2212 by 1659 pixels:
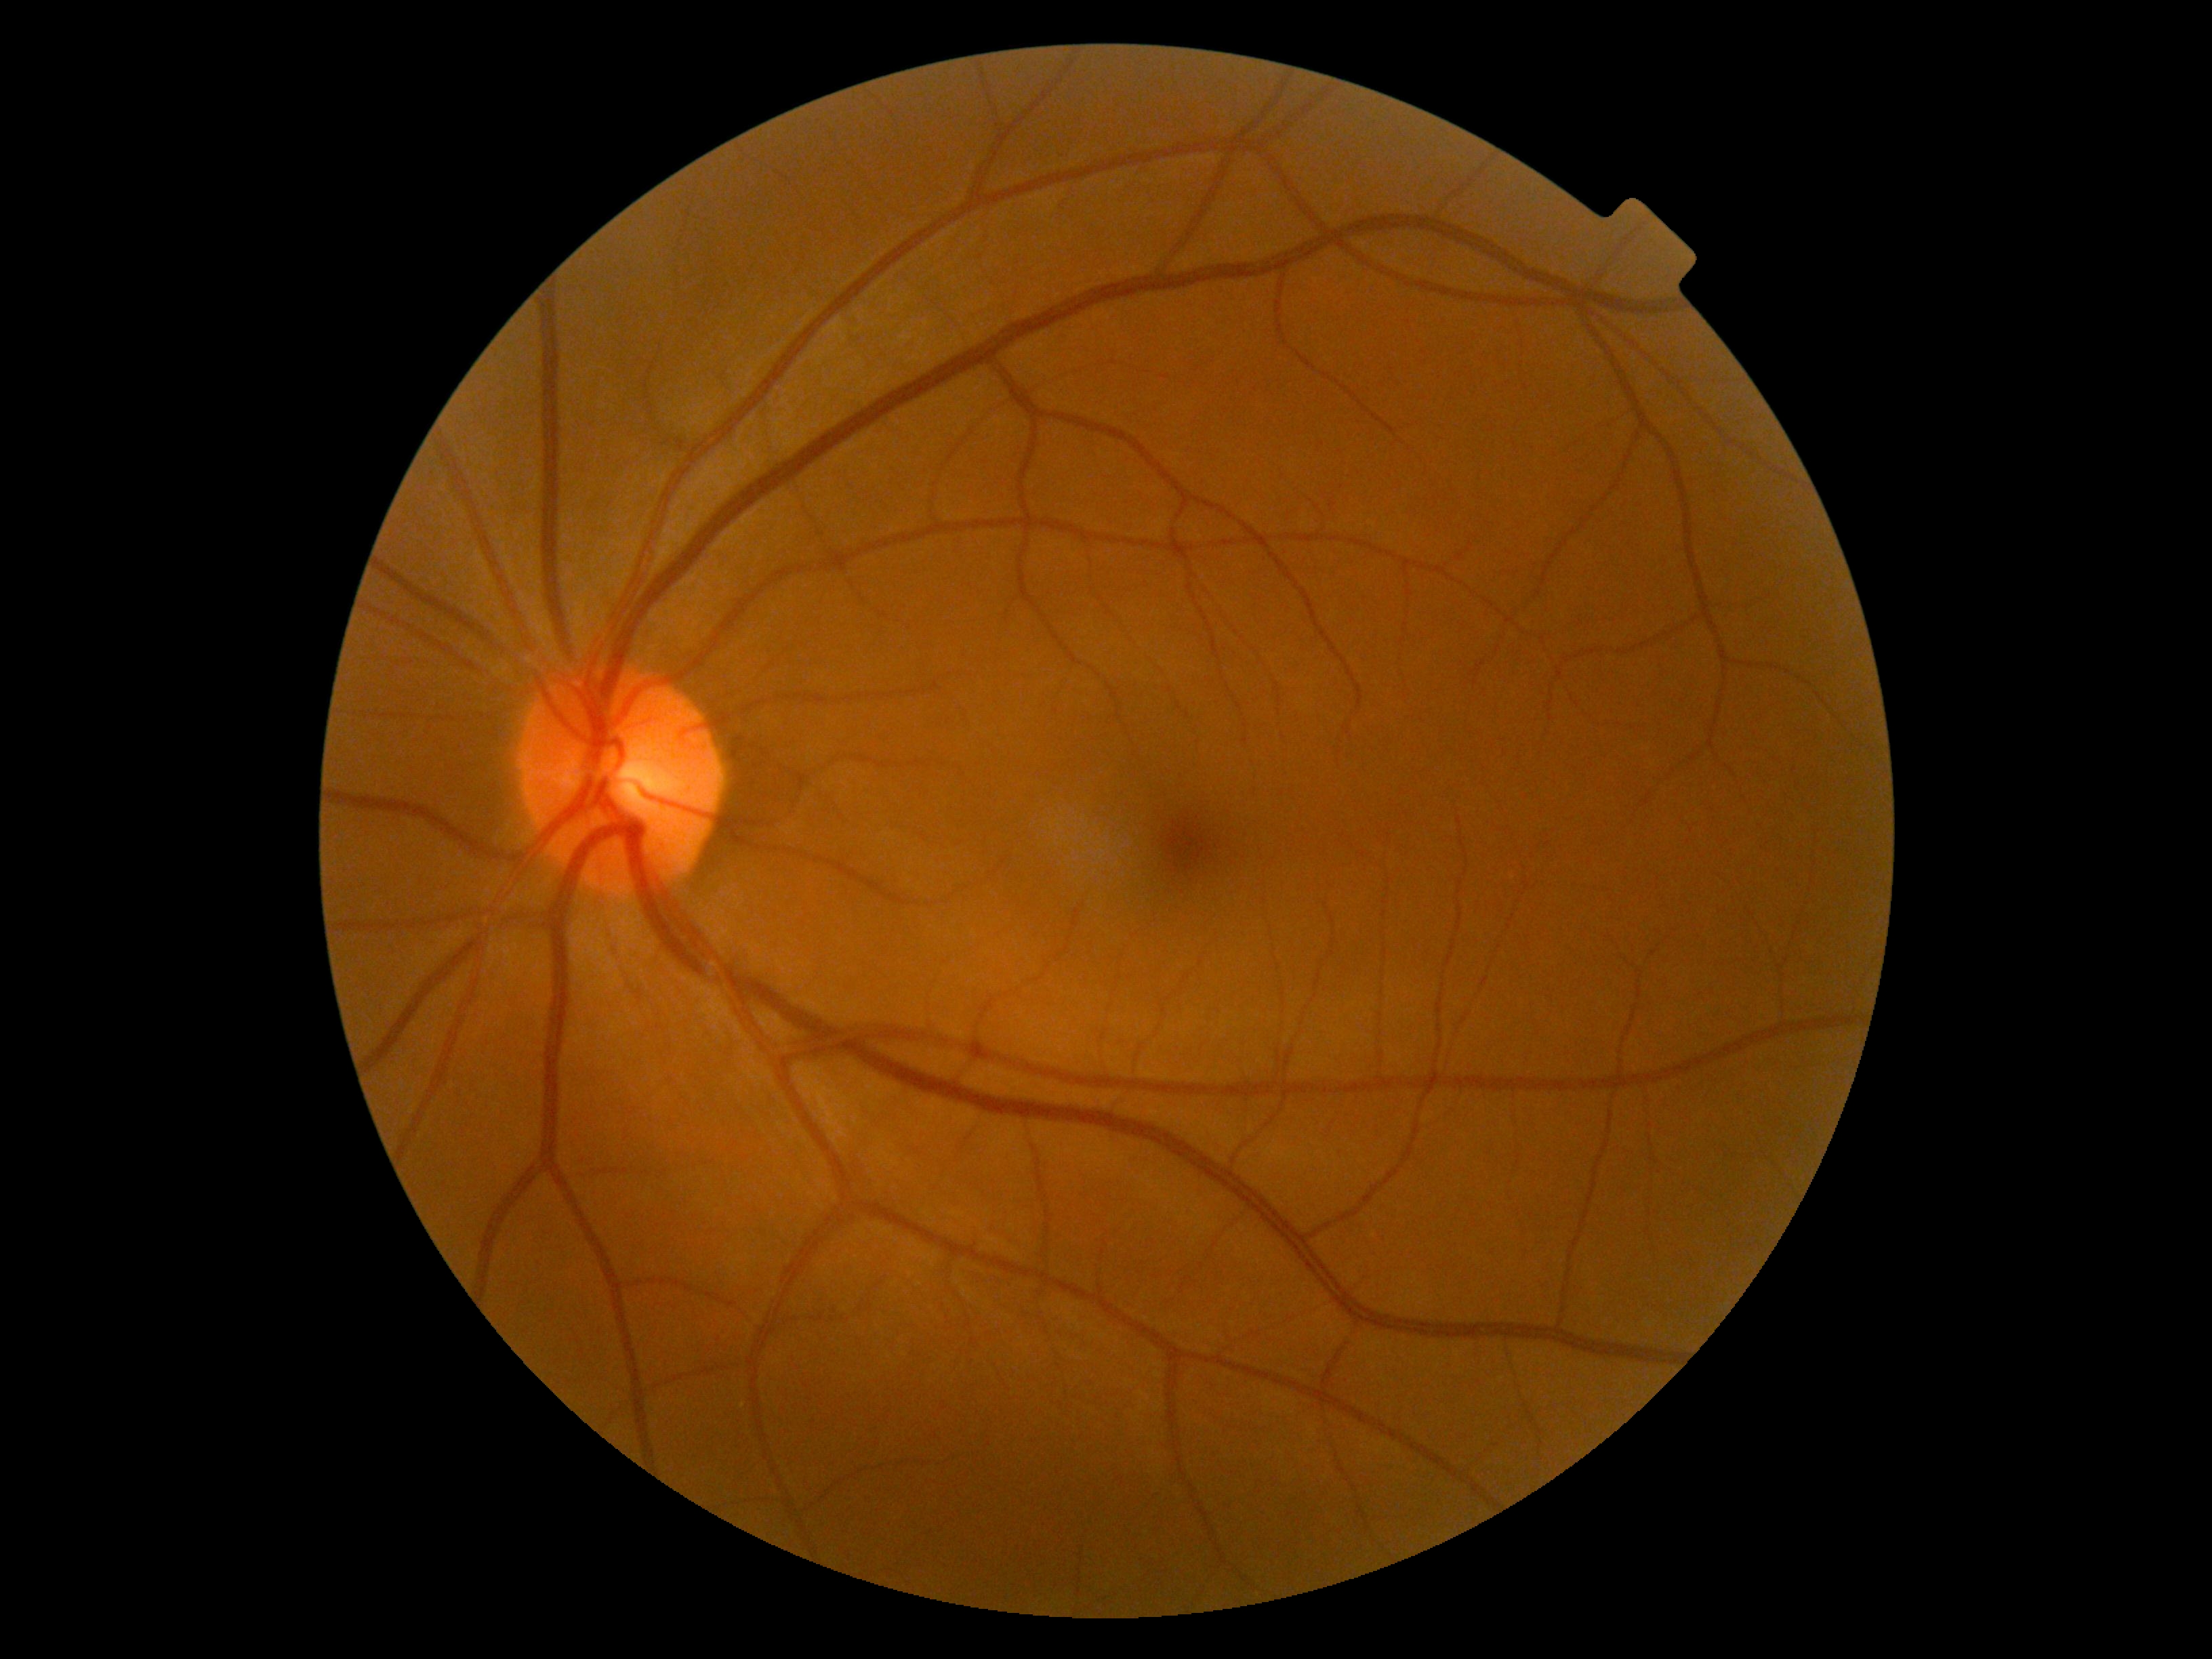

Diabetic retinopathy (DR) is 0.